No pharmacologic dilation, Davis DR grading, fundus photo: 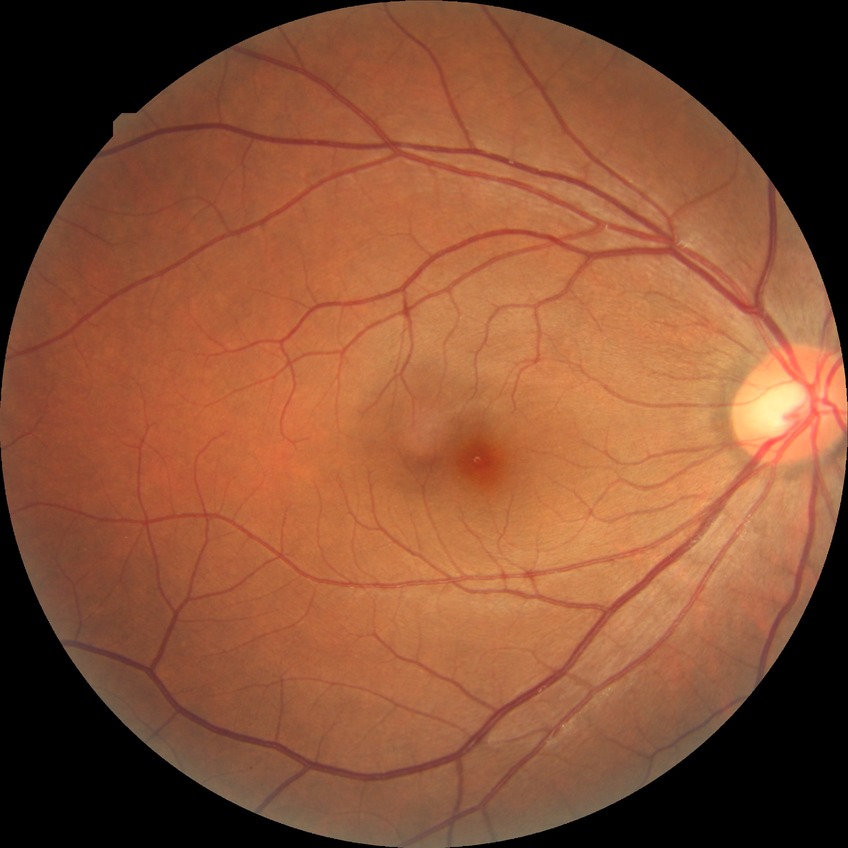 Diabetic retinopathy grade: no diabetic retinopathy.